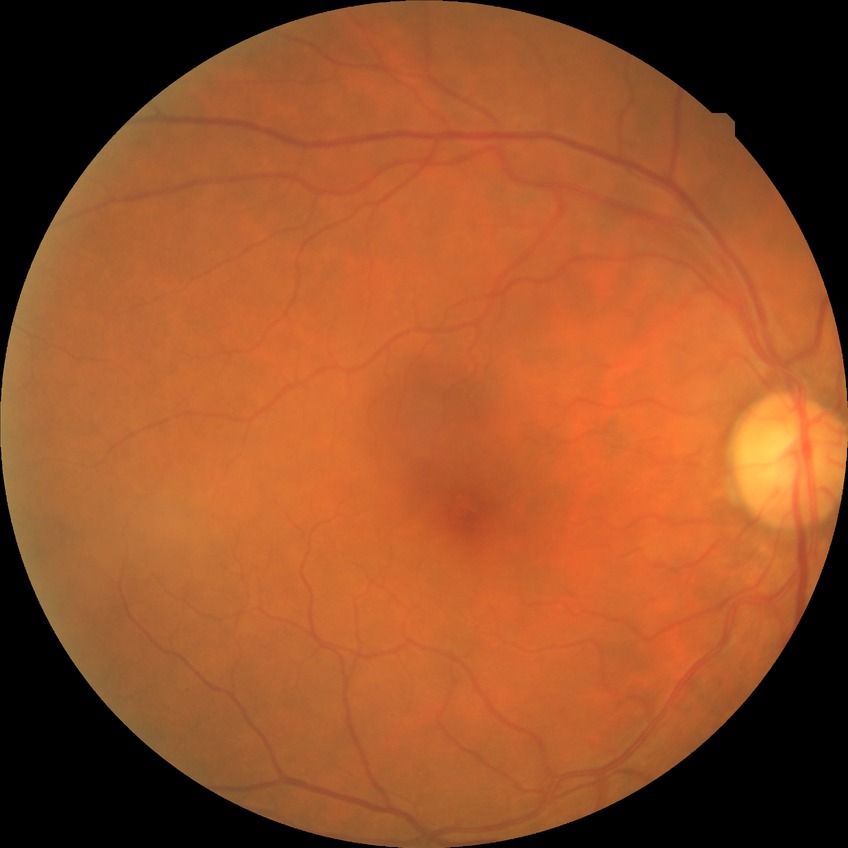

Diabetic retinopathy (DR) is NDR (no diabetic retinopathy).